Non-mydriatic fundus camera. Acquired with a Nidek AFC-330. Optic nerve head crop
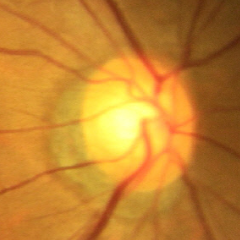 Assessment = no glaucomatous changes.